Camera: NIDEK AFC-230
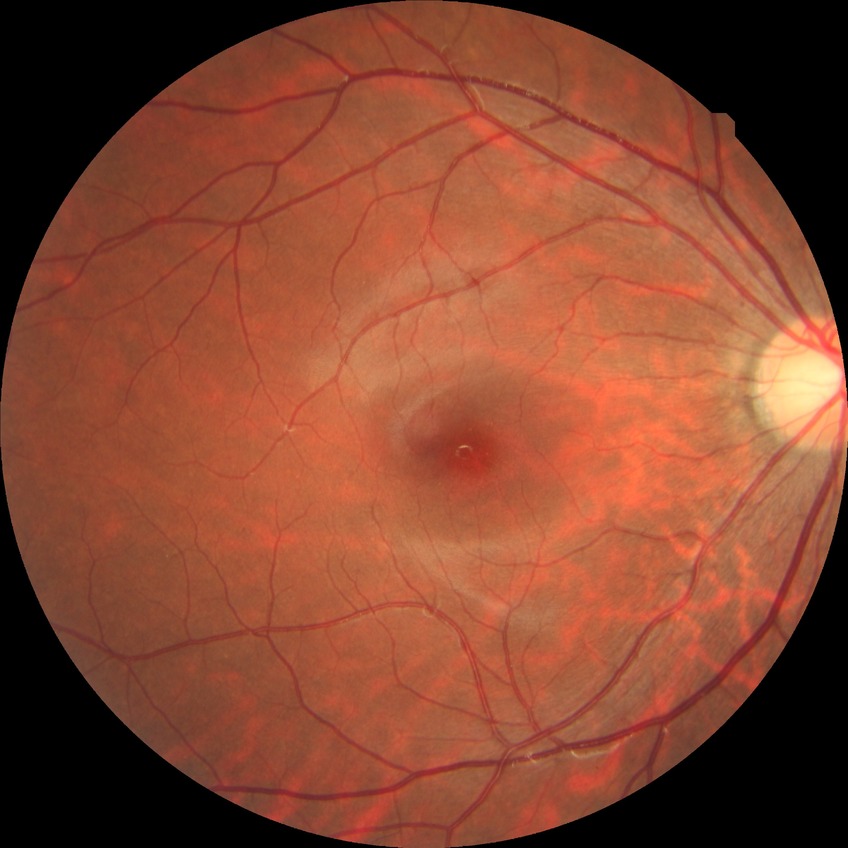 {"davis_grade": "no diabetic retinopathy (NDR)"}